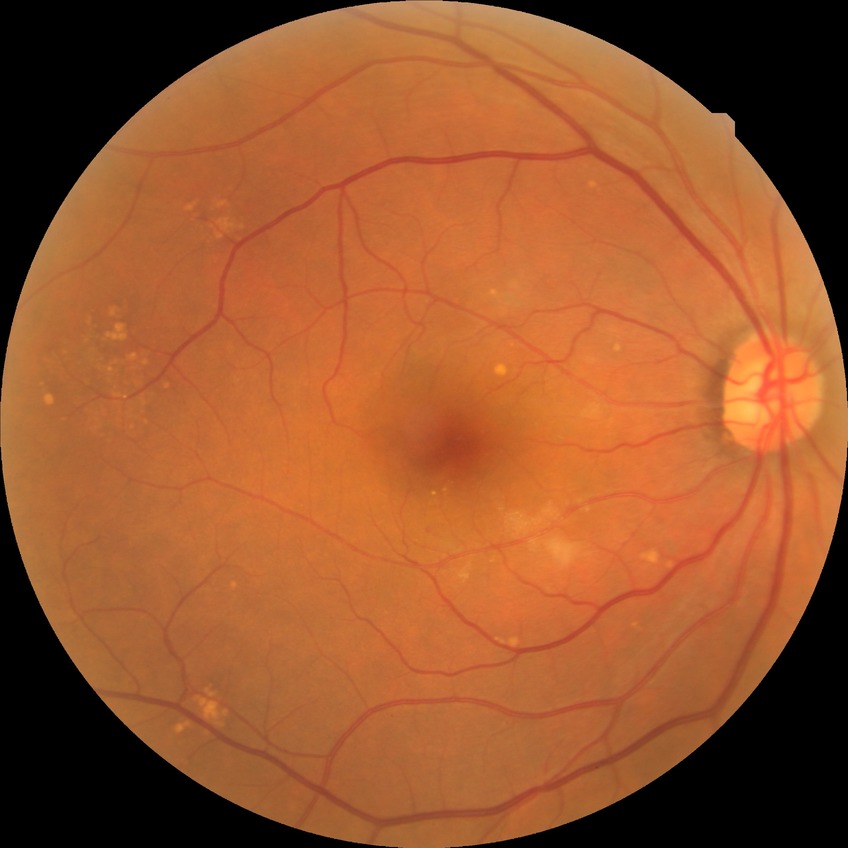

DR severity: NDR.
No signs of diabetic retinopathy.